Pediatric retinal photograph (wide-field); acquired on the Phoenix ICON — 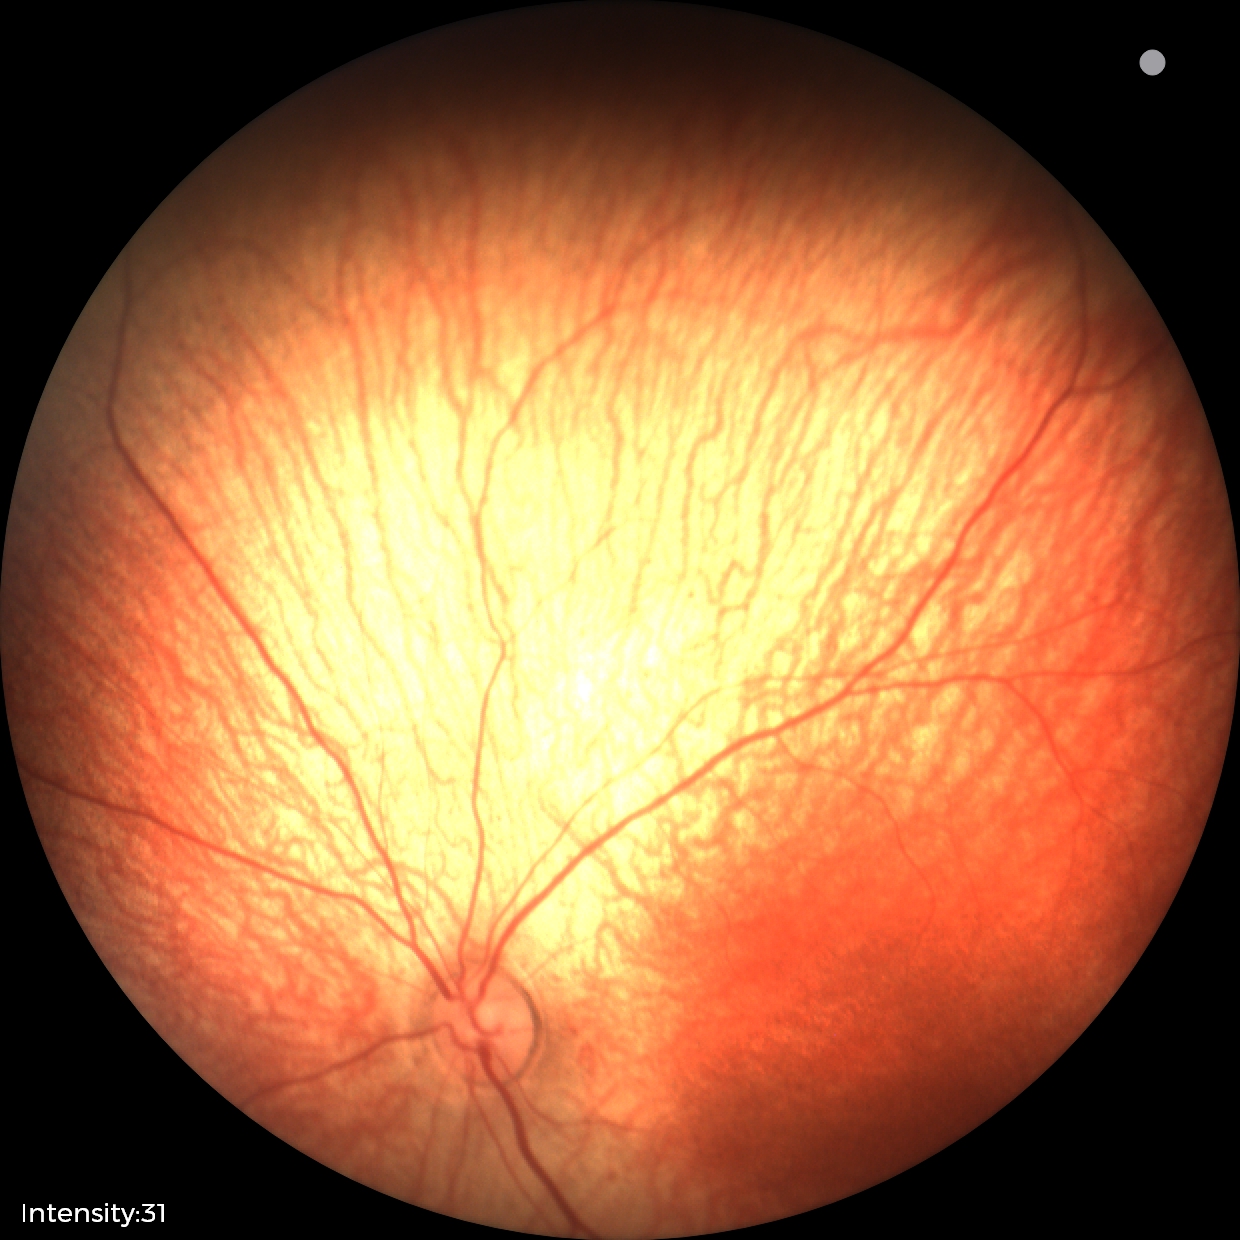

Screening examination diagnosed as physiological.